Retinal fundus photograph
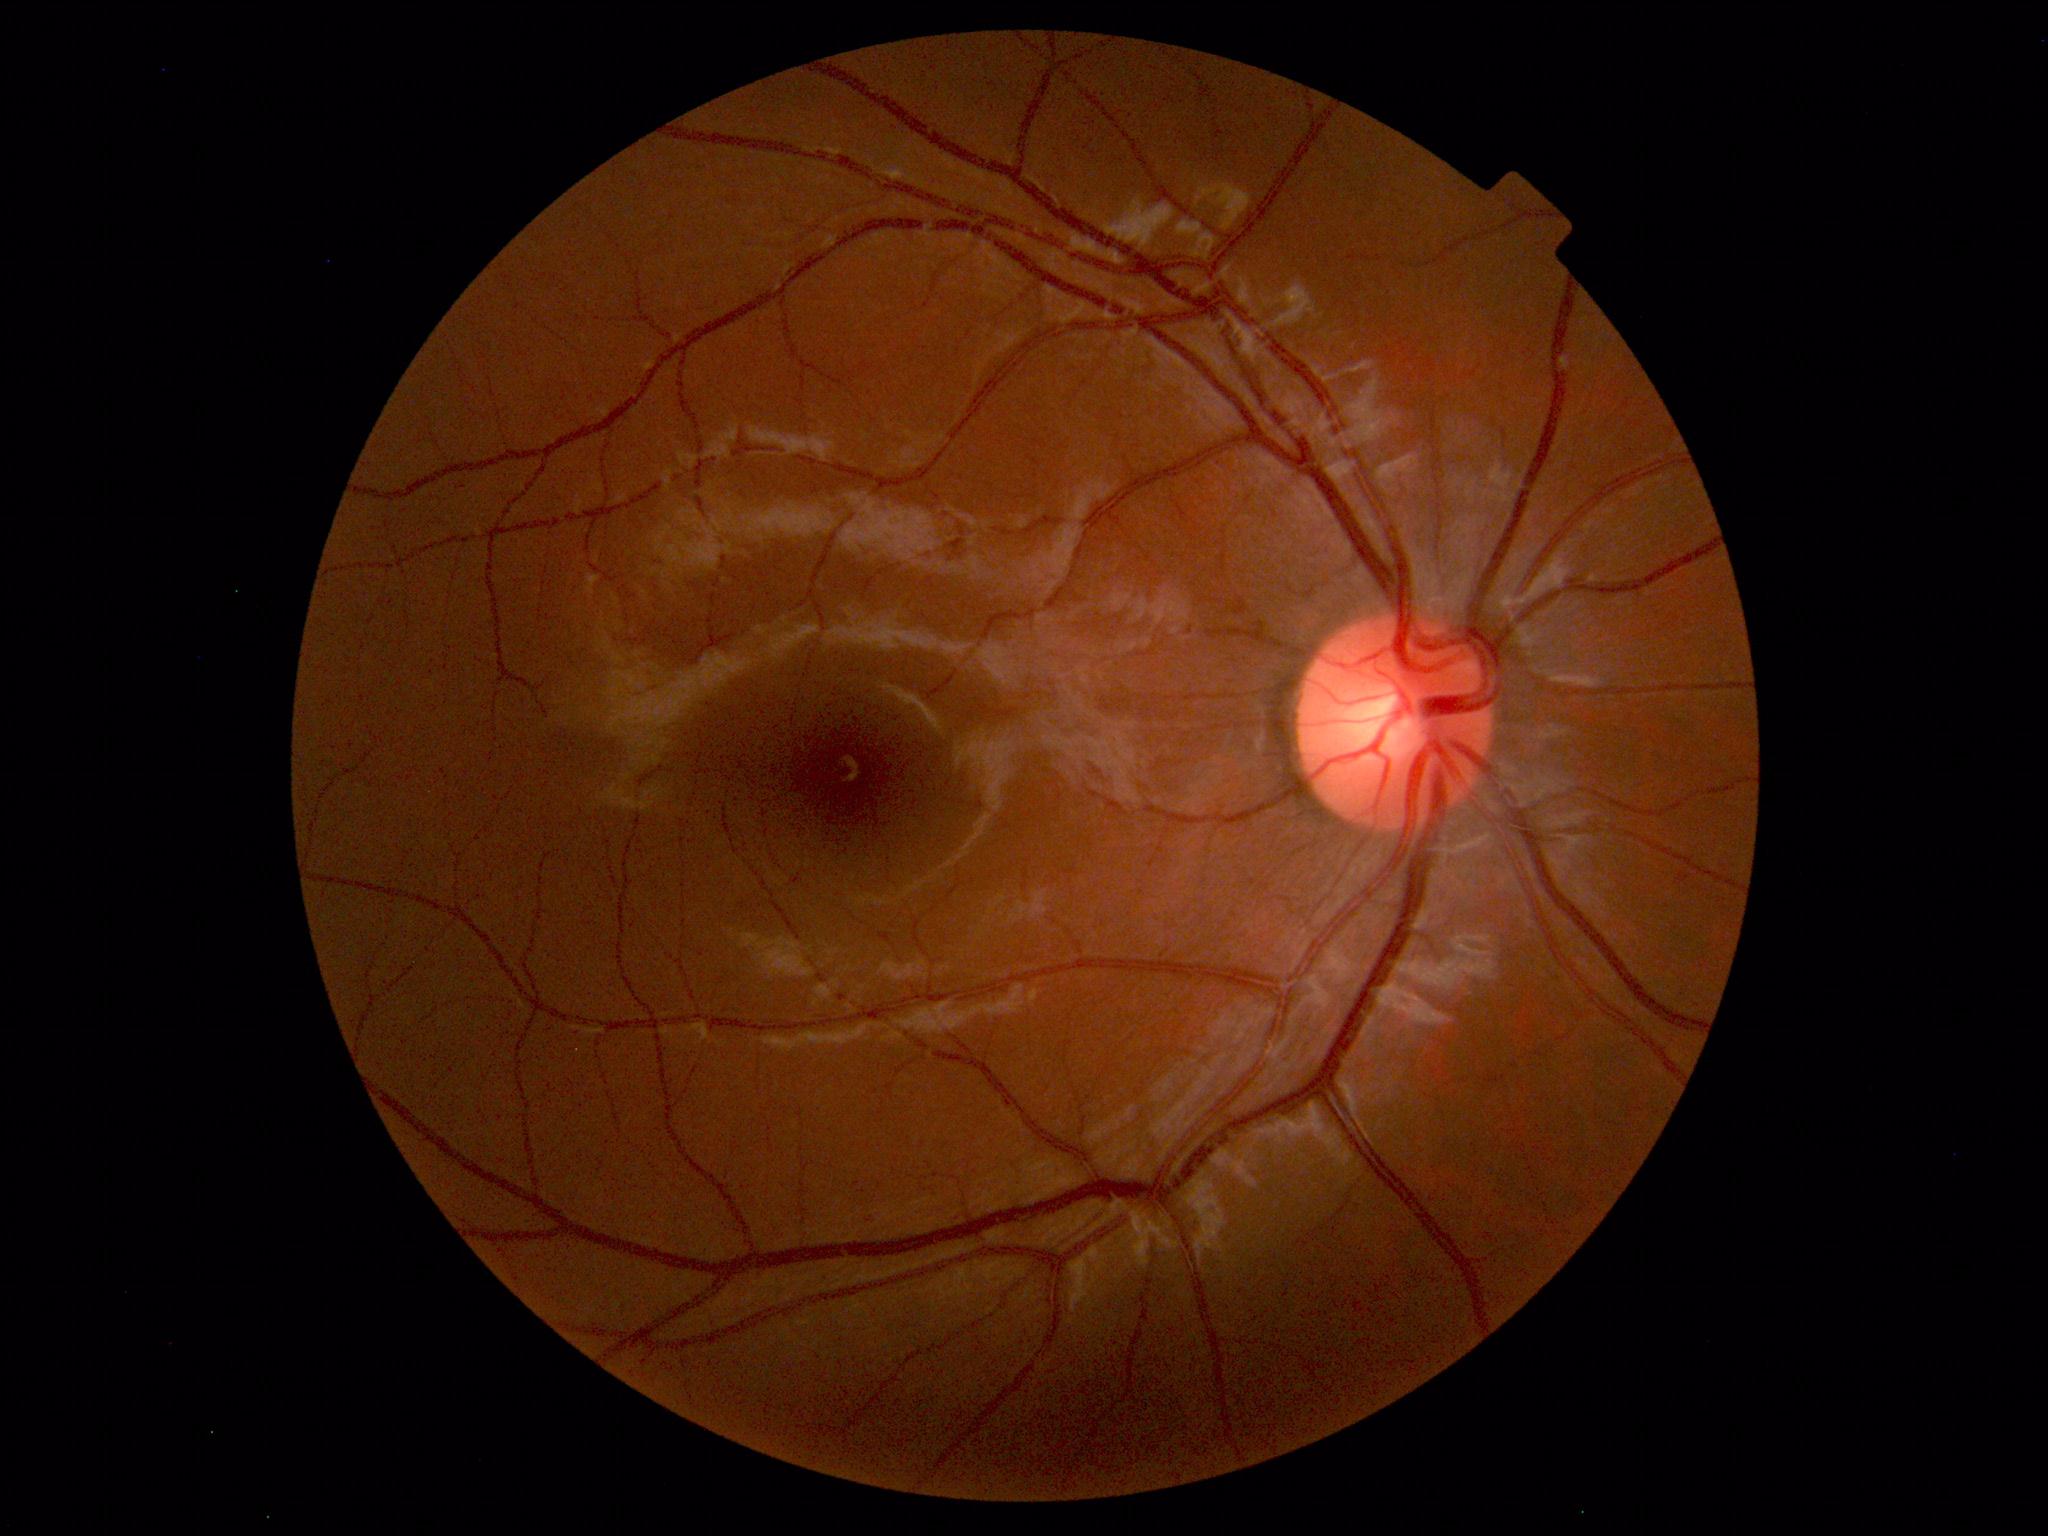
Diagnosis: normal.